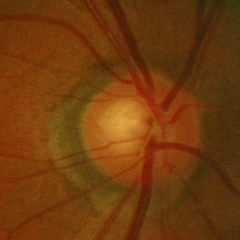
Optic disc photograph demonstrating early glaucomatous changes. Diagnostic criteria: glaucomatous retinal nerve fiber layer defects on red-free fundus photography without visual field defects.